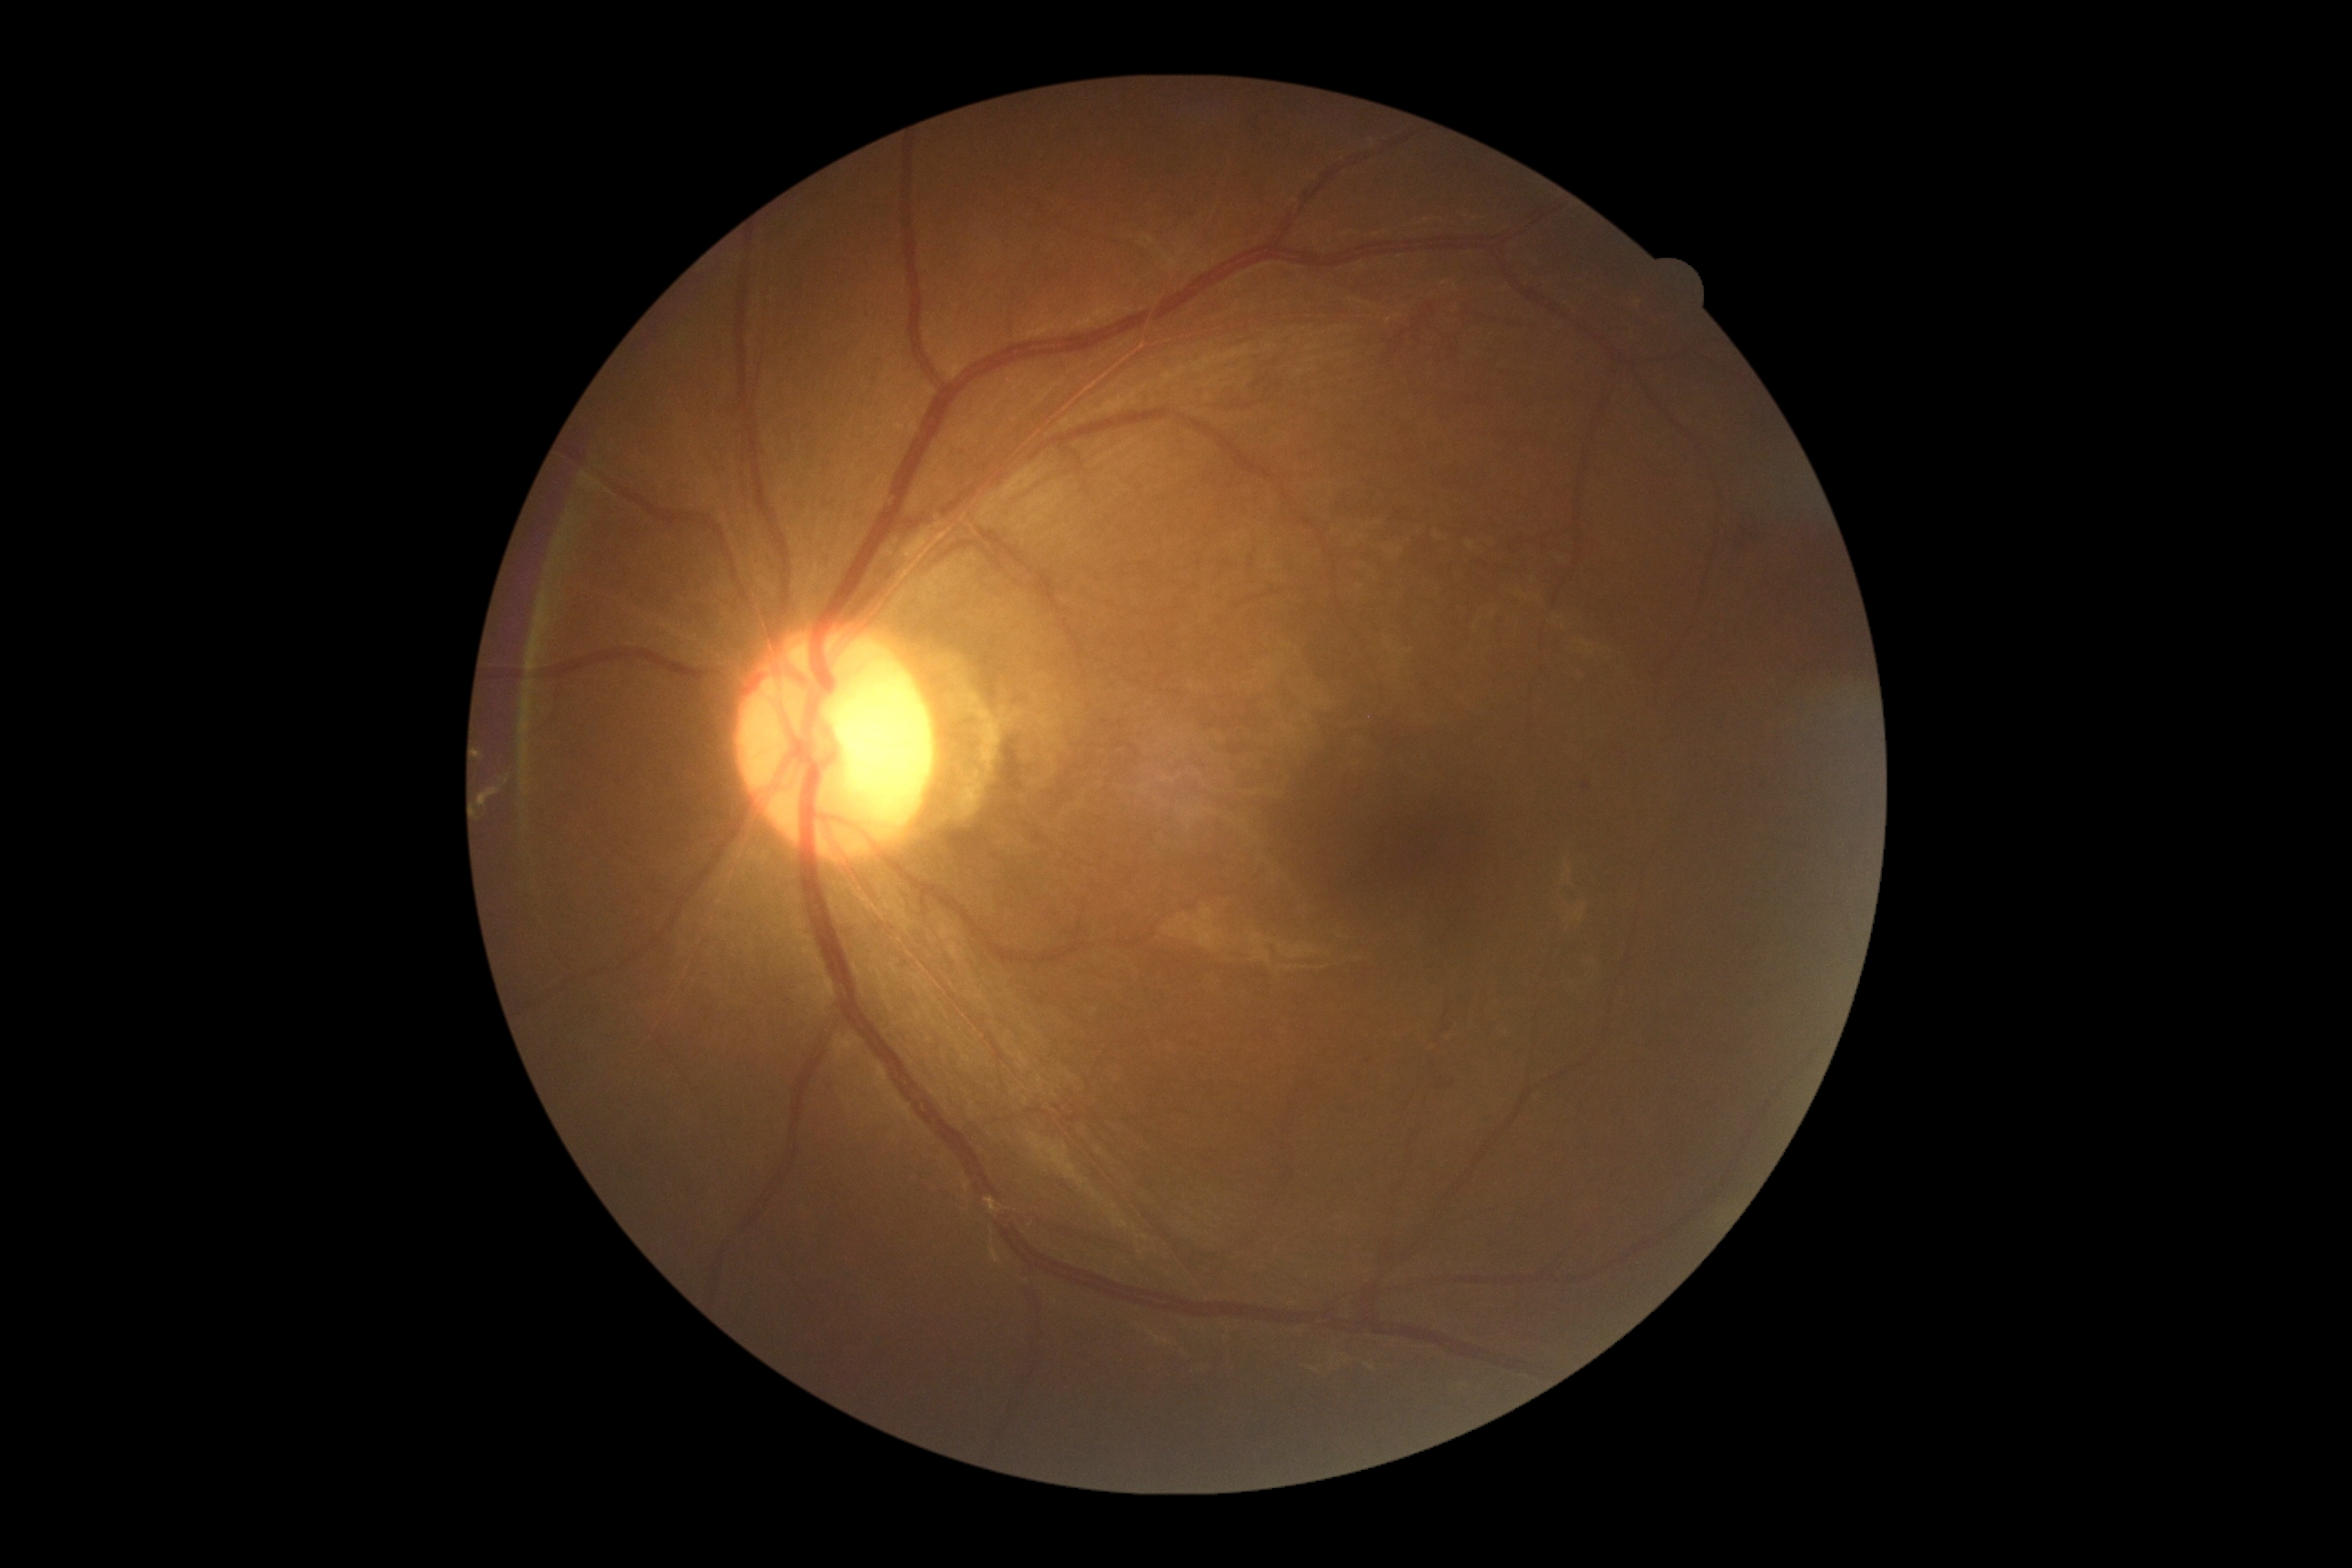 DR severity is moderate non-proliferative diabetic retinopathy (grade 2).